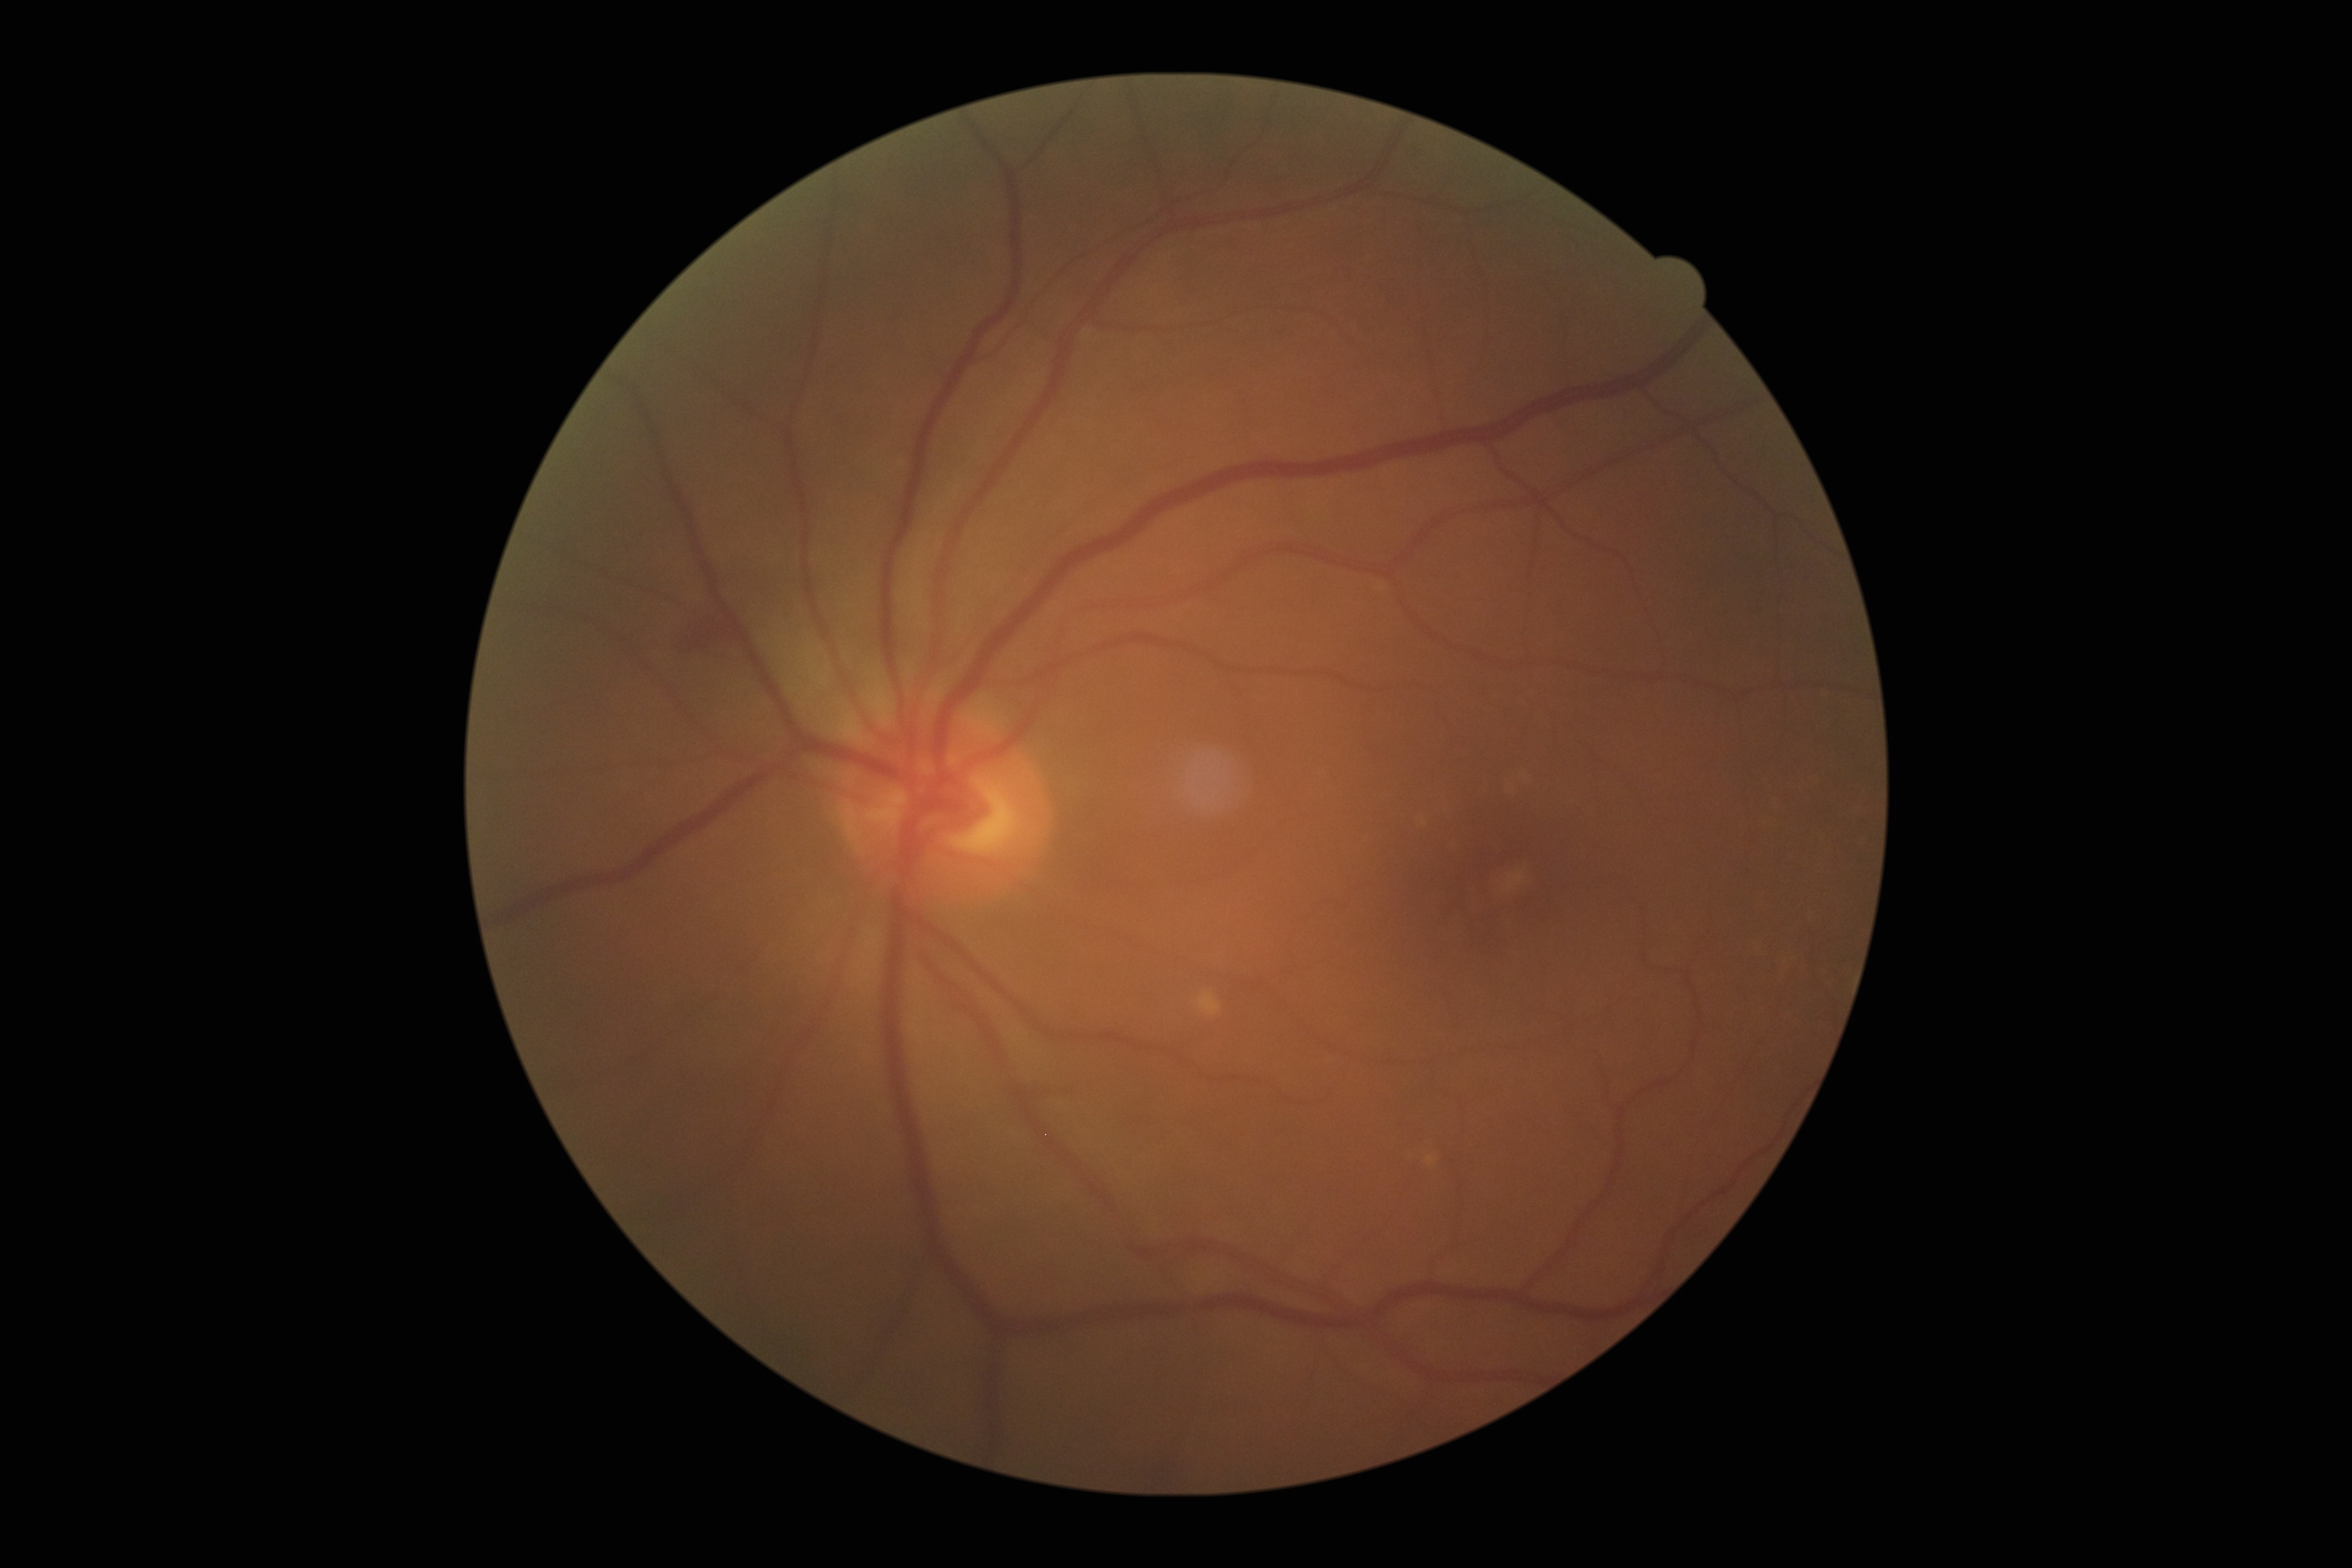
The retinopathy is classified as non-proliferative diabetic retinopathy. DR severity: grade 2 (moderate NPDR).